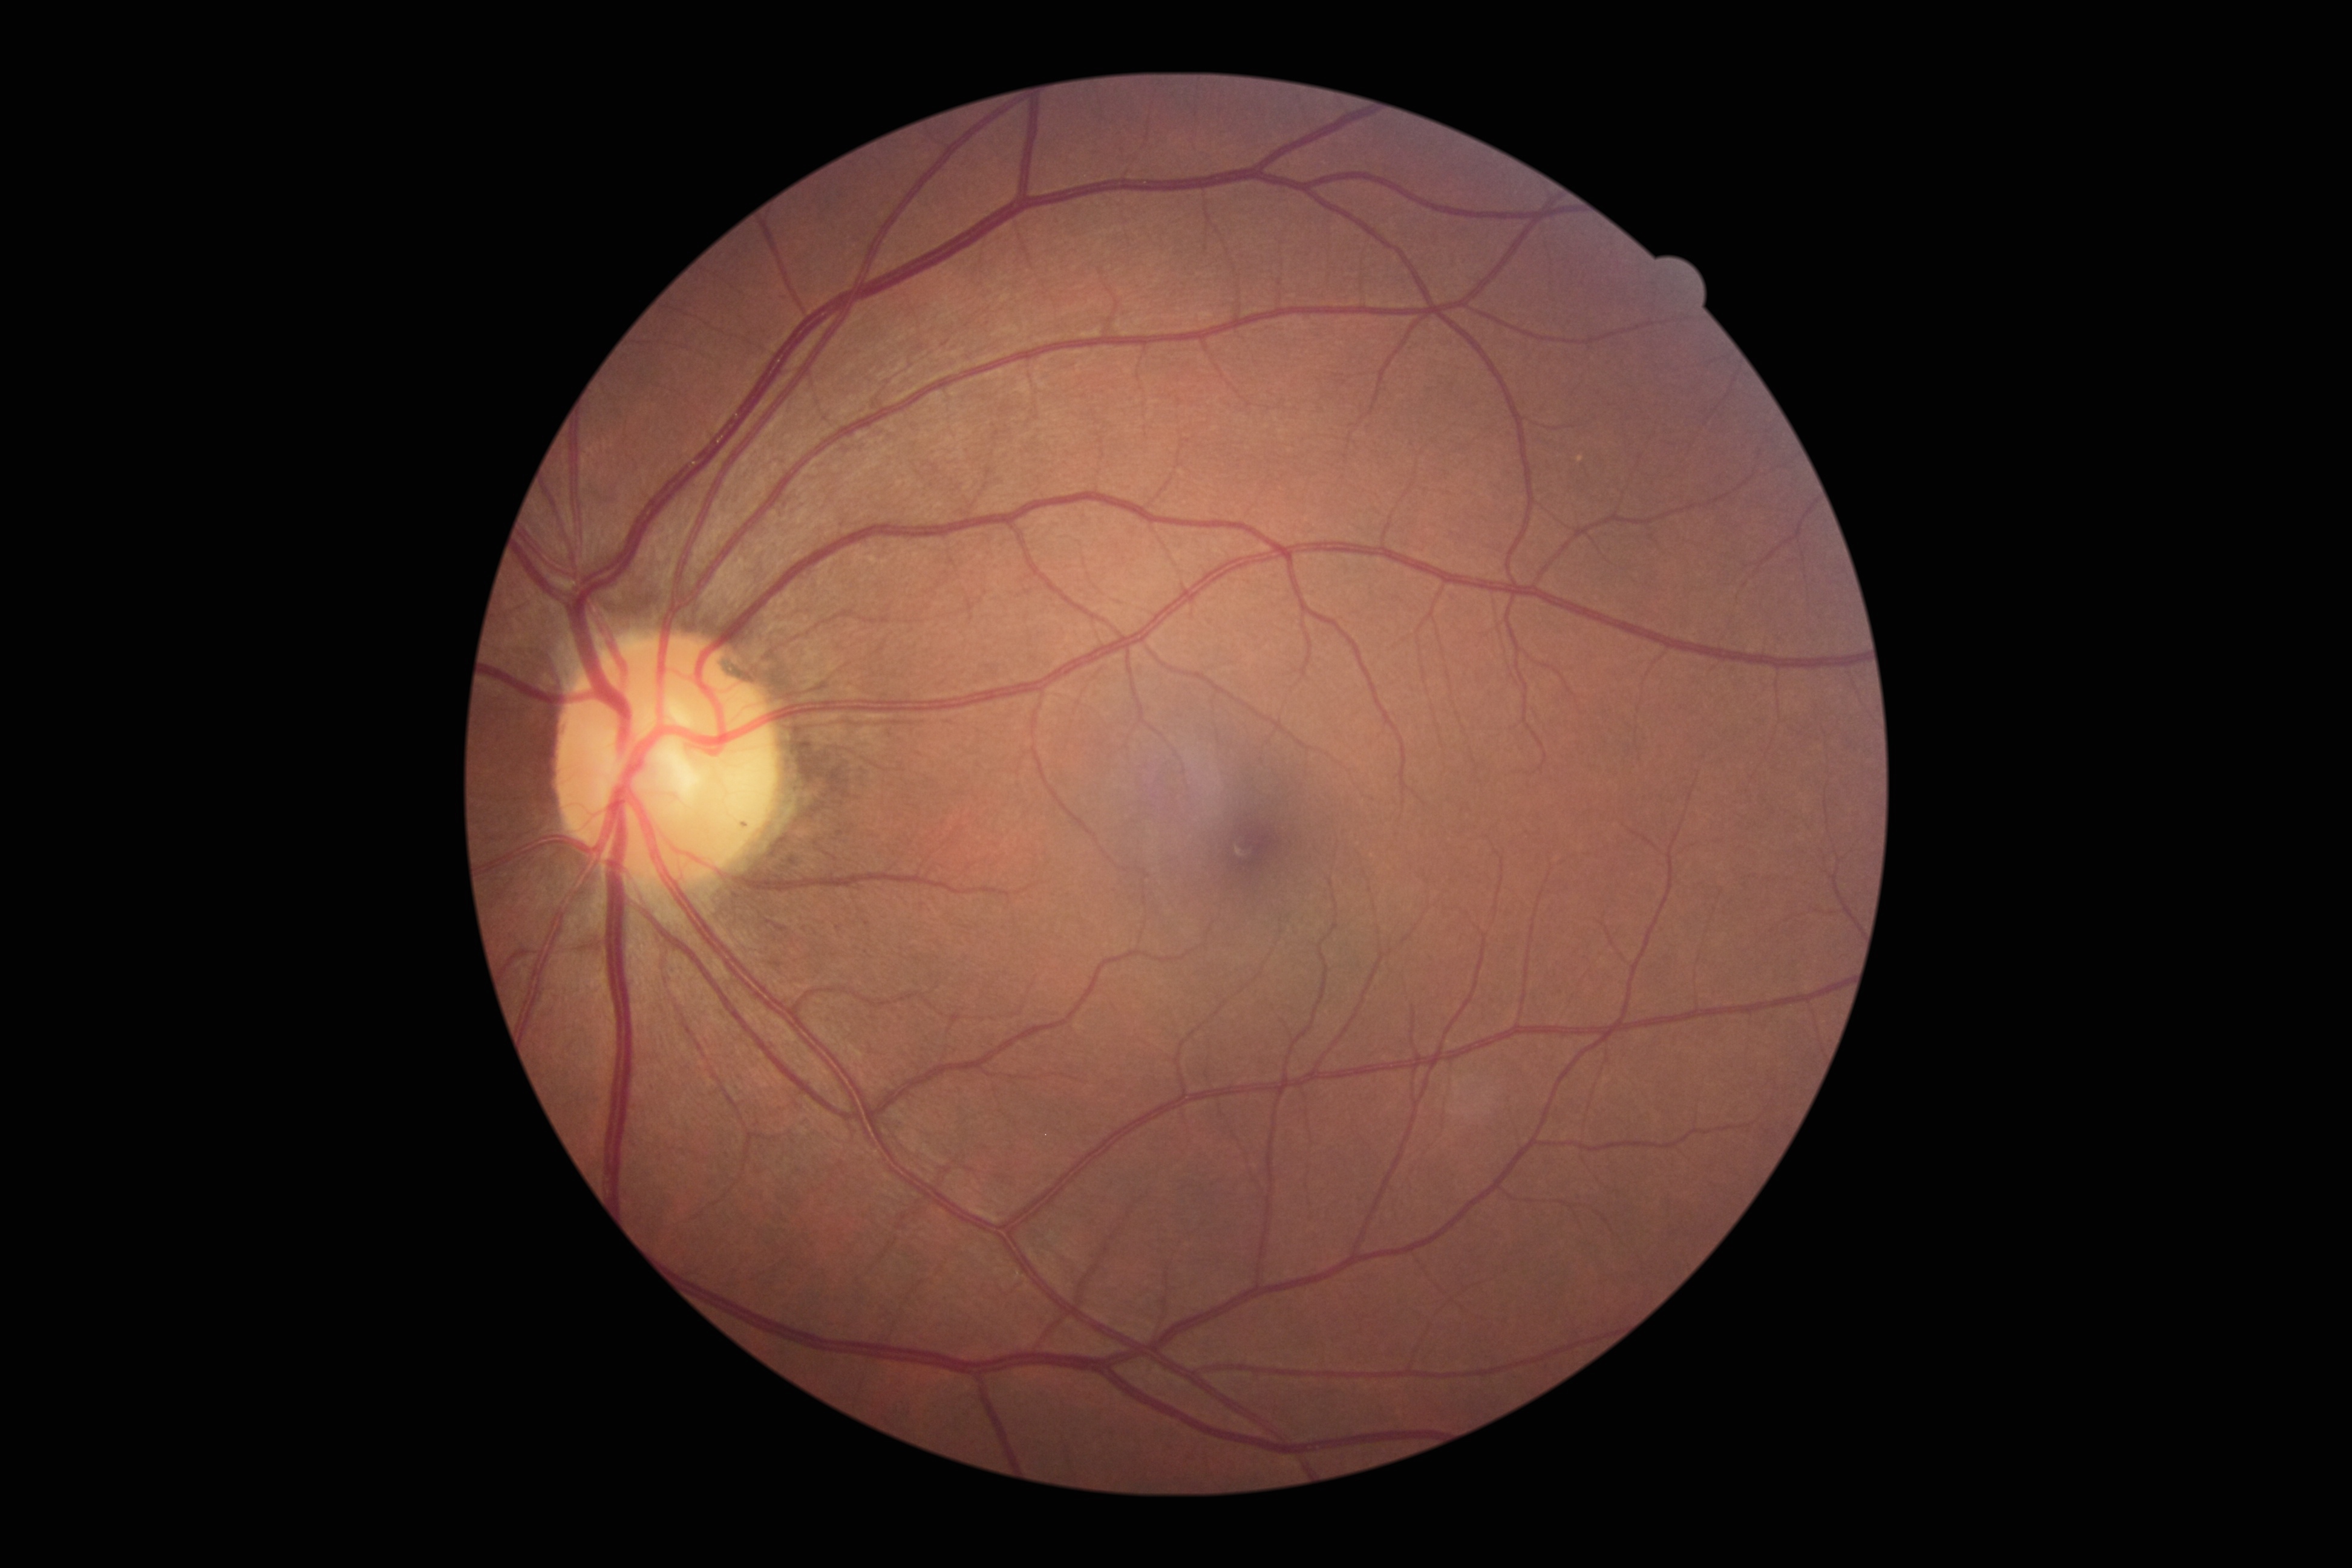
DR severity is no apparent diabetic retinopathy (grade 0).